Camera: NIDEK AFC-230, DR severity per modified Davis staging:
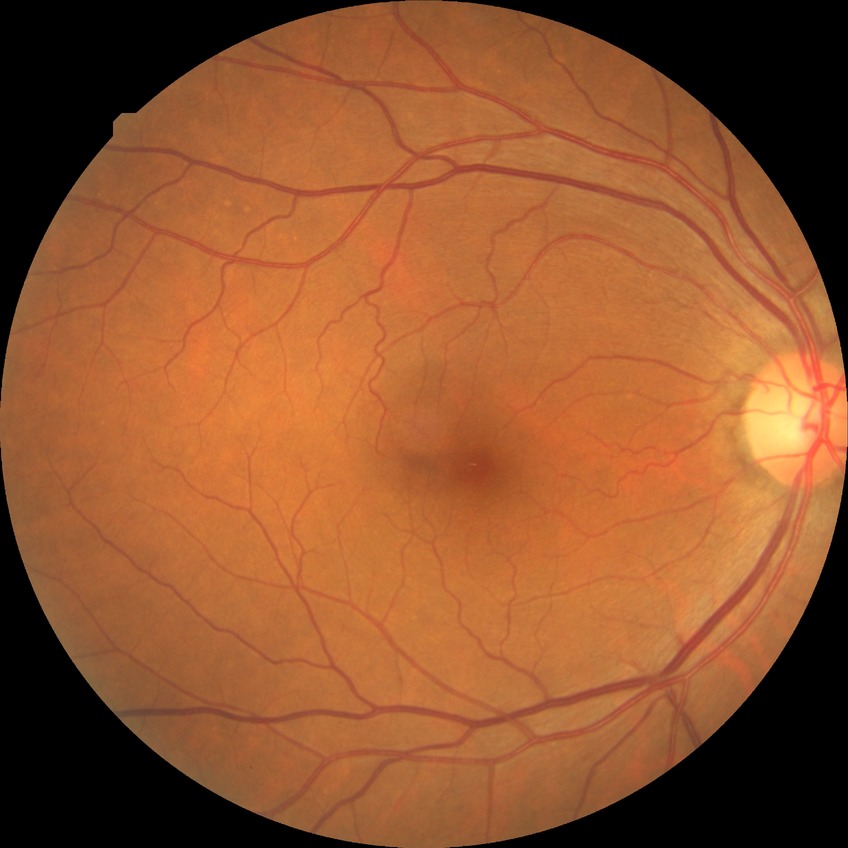 diabetic retinopathy (DR): NDR (no diabetic retinopathy).